Retinal fundus photograph. FOV: 45 degrees. 2352 x 1568 pixels — 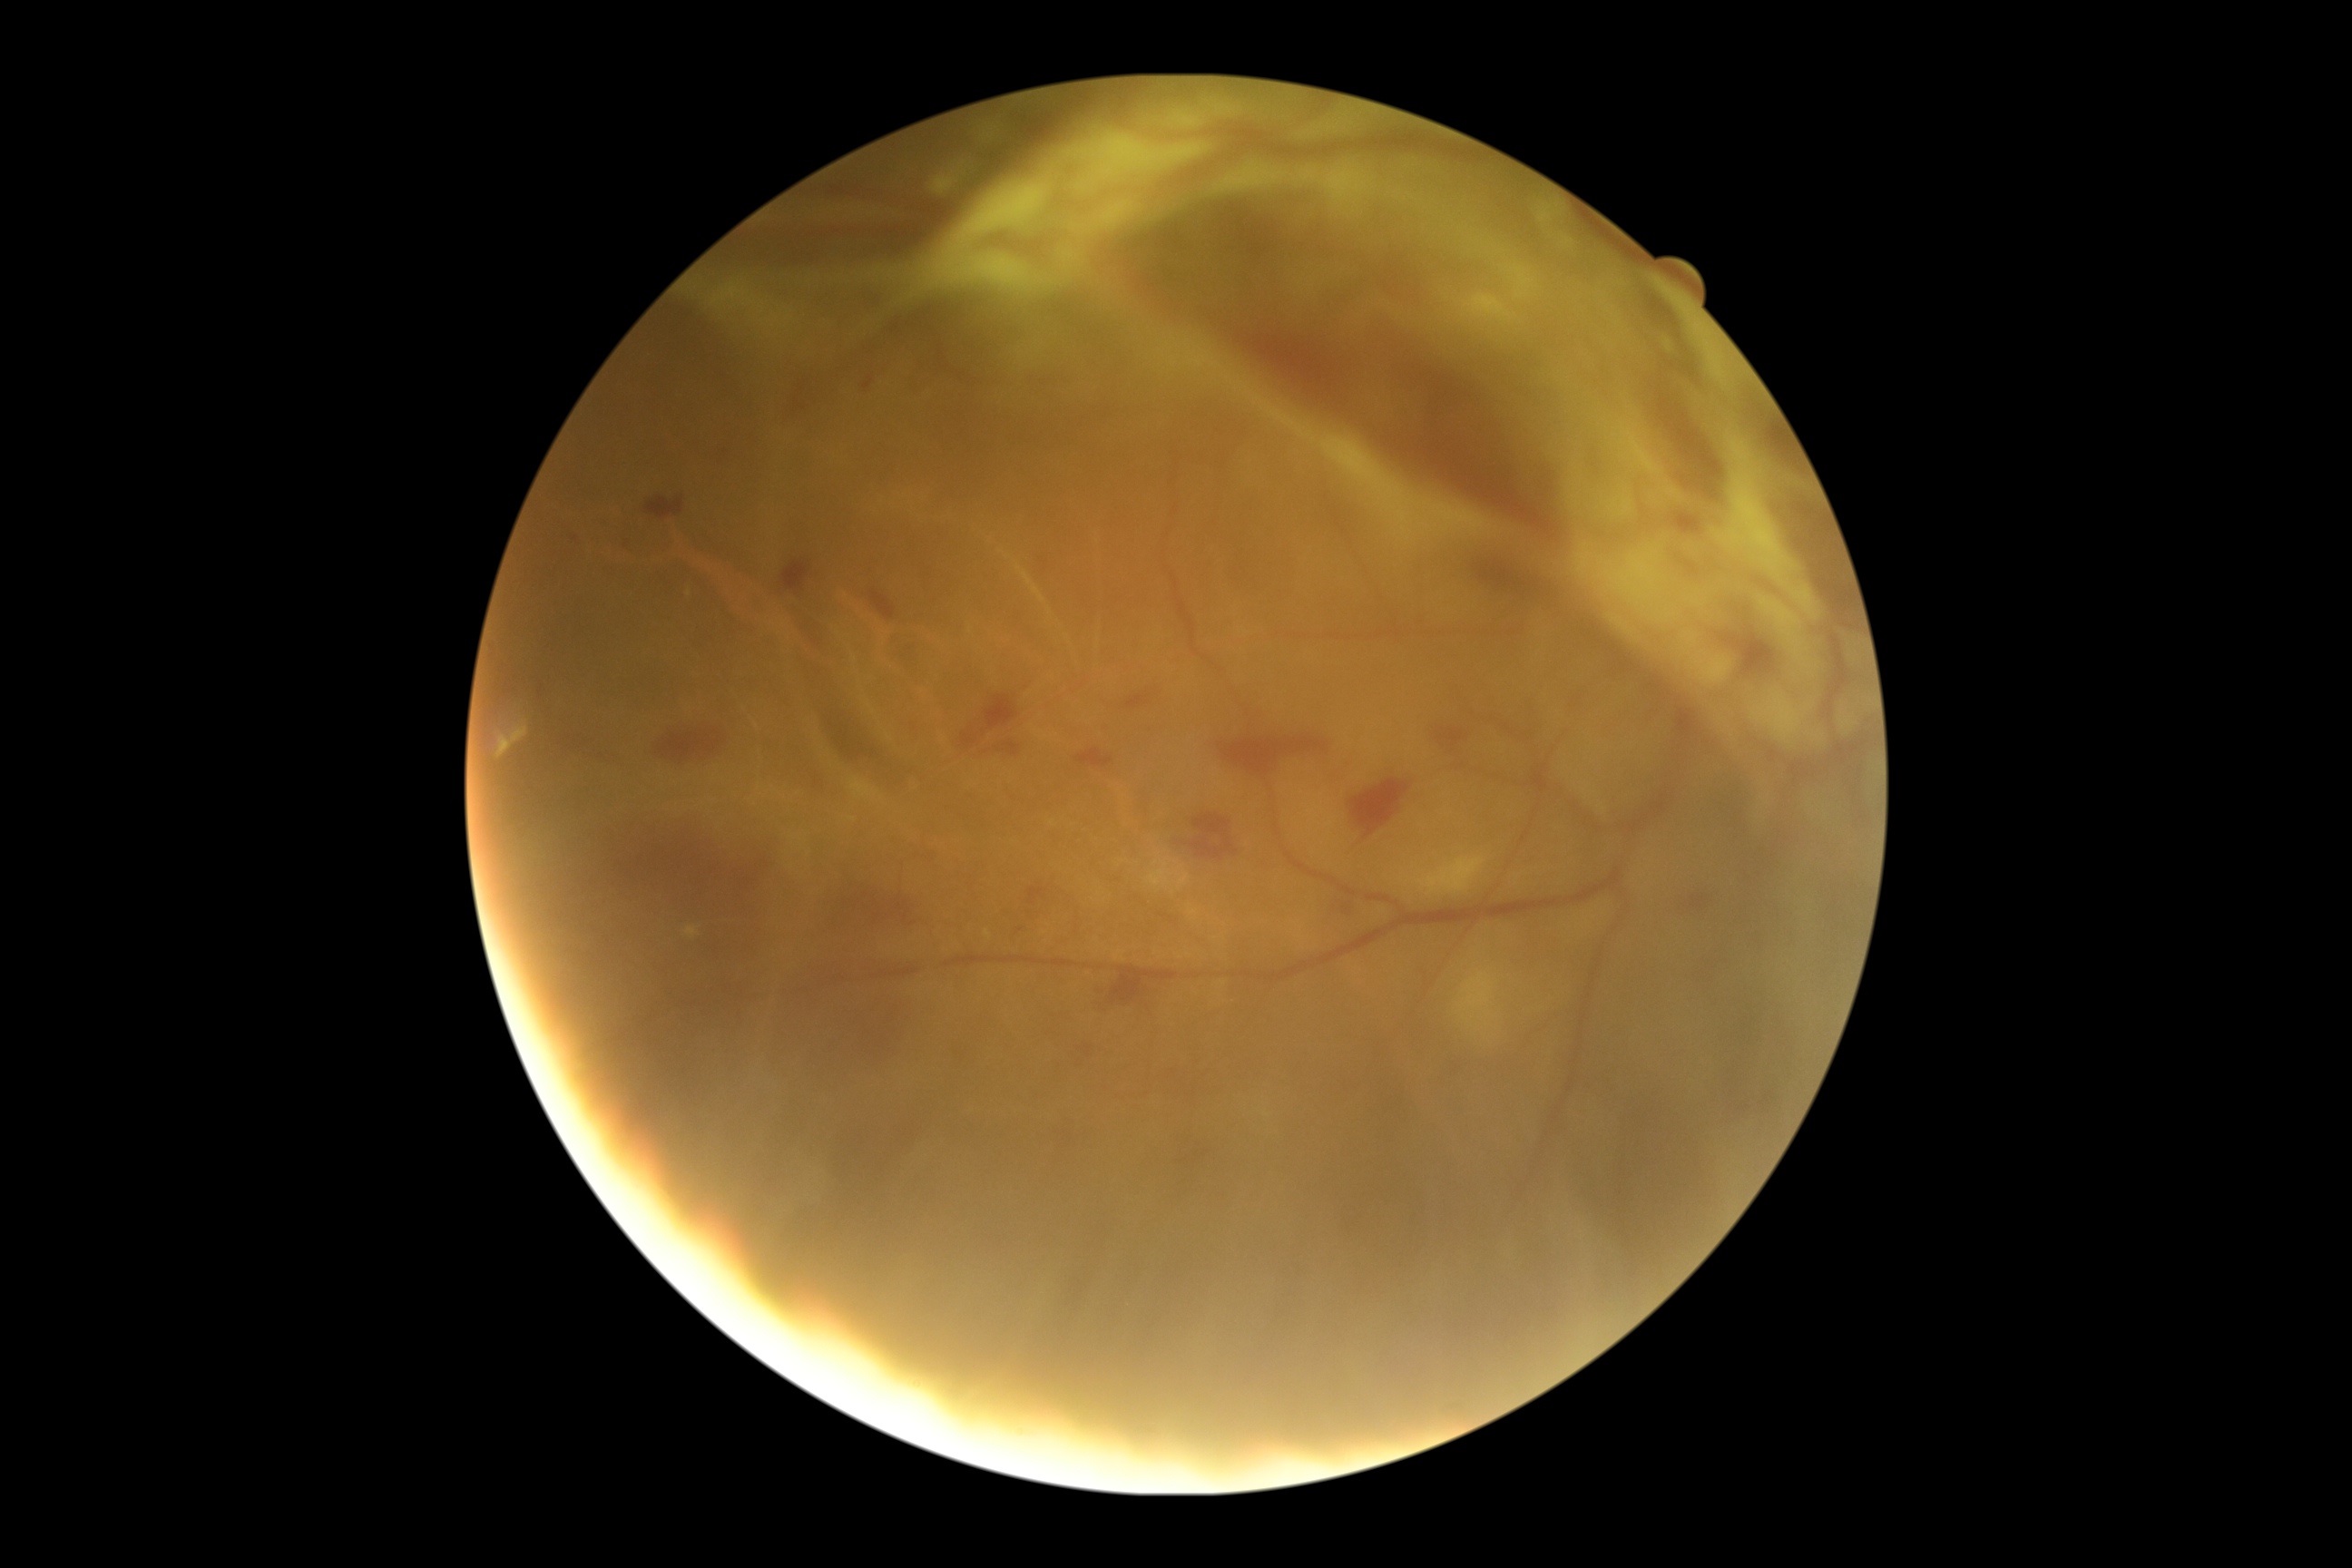
{
  "dr_grade": "proliferative diabetic retinopathy (4)",
  "dr_category": "proliferative diabetic retinopathy"
}